Infant wide-field retinal image.
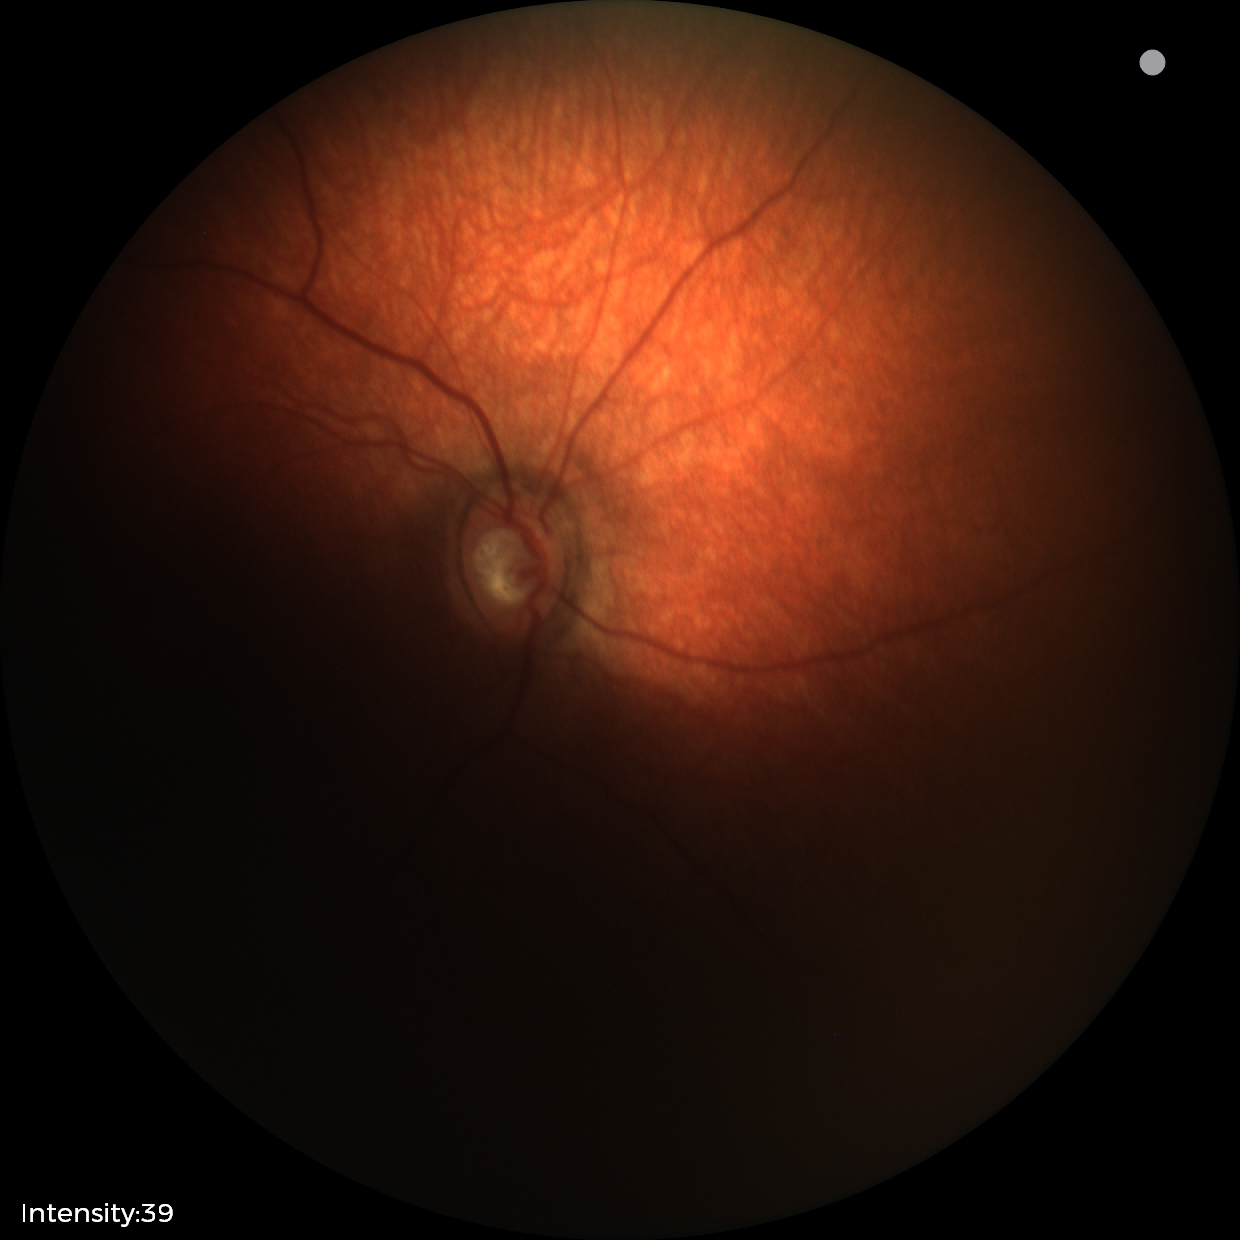
Assessment = no pathology identified.